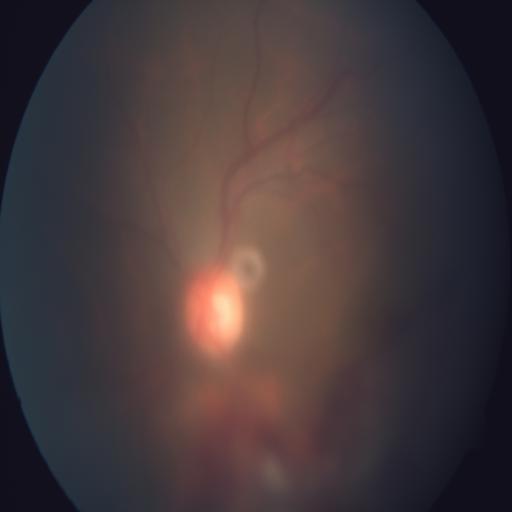

Diagnosis (2): media haze, preretinal hemorrhage.